240 x 240 pixels; camera: Nidek AFC-330 — 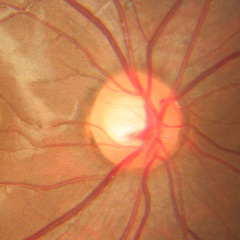

Assessment = no glaucomatous findings.